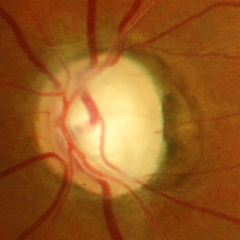 There is evidence of early glaucomatous changes.